1240 x 1240 pixels; wide-field contact fundus photograph of an infant; acquired on the Phoenix ICON: 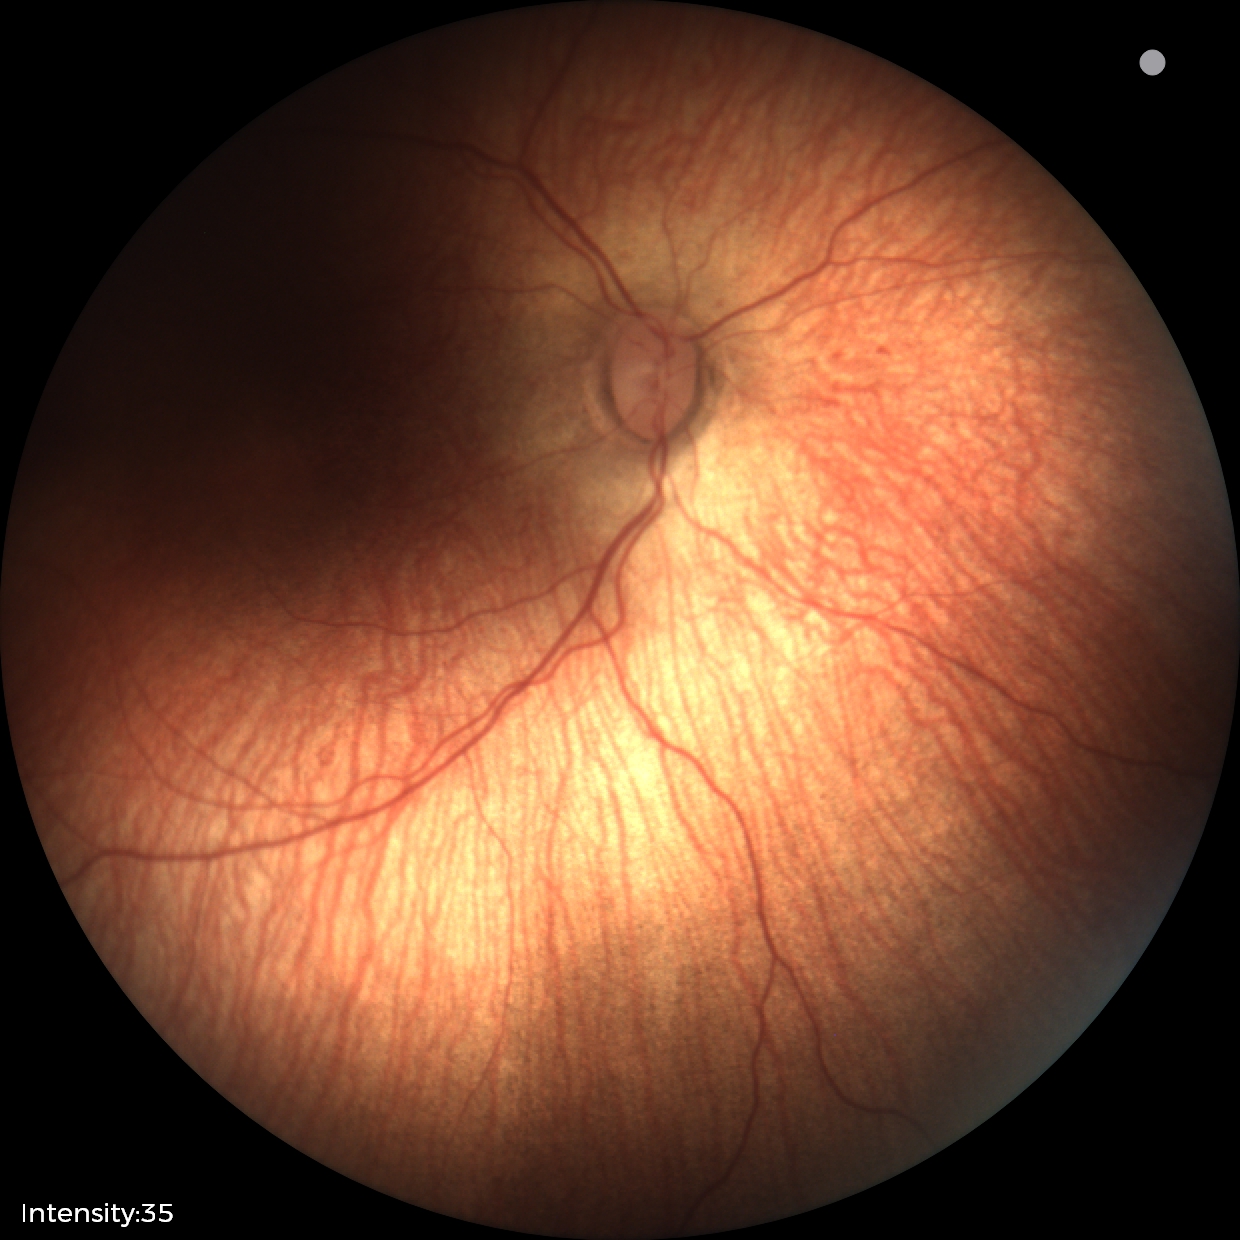
Plus form = absent; screening diagnosis = status post ROP.